200° FOV
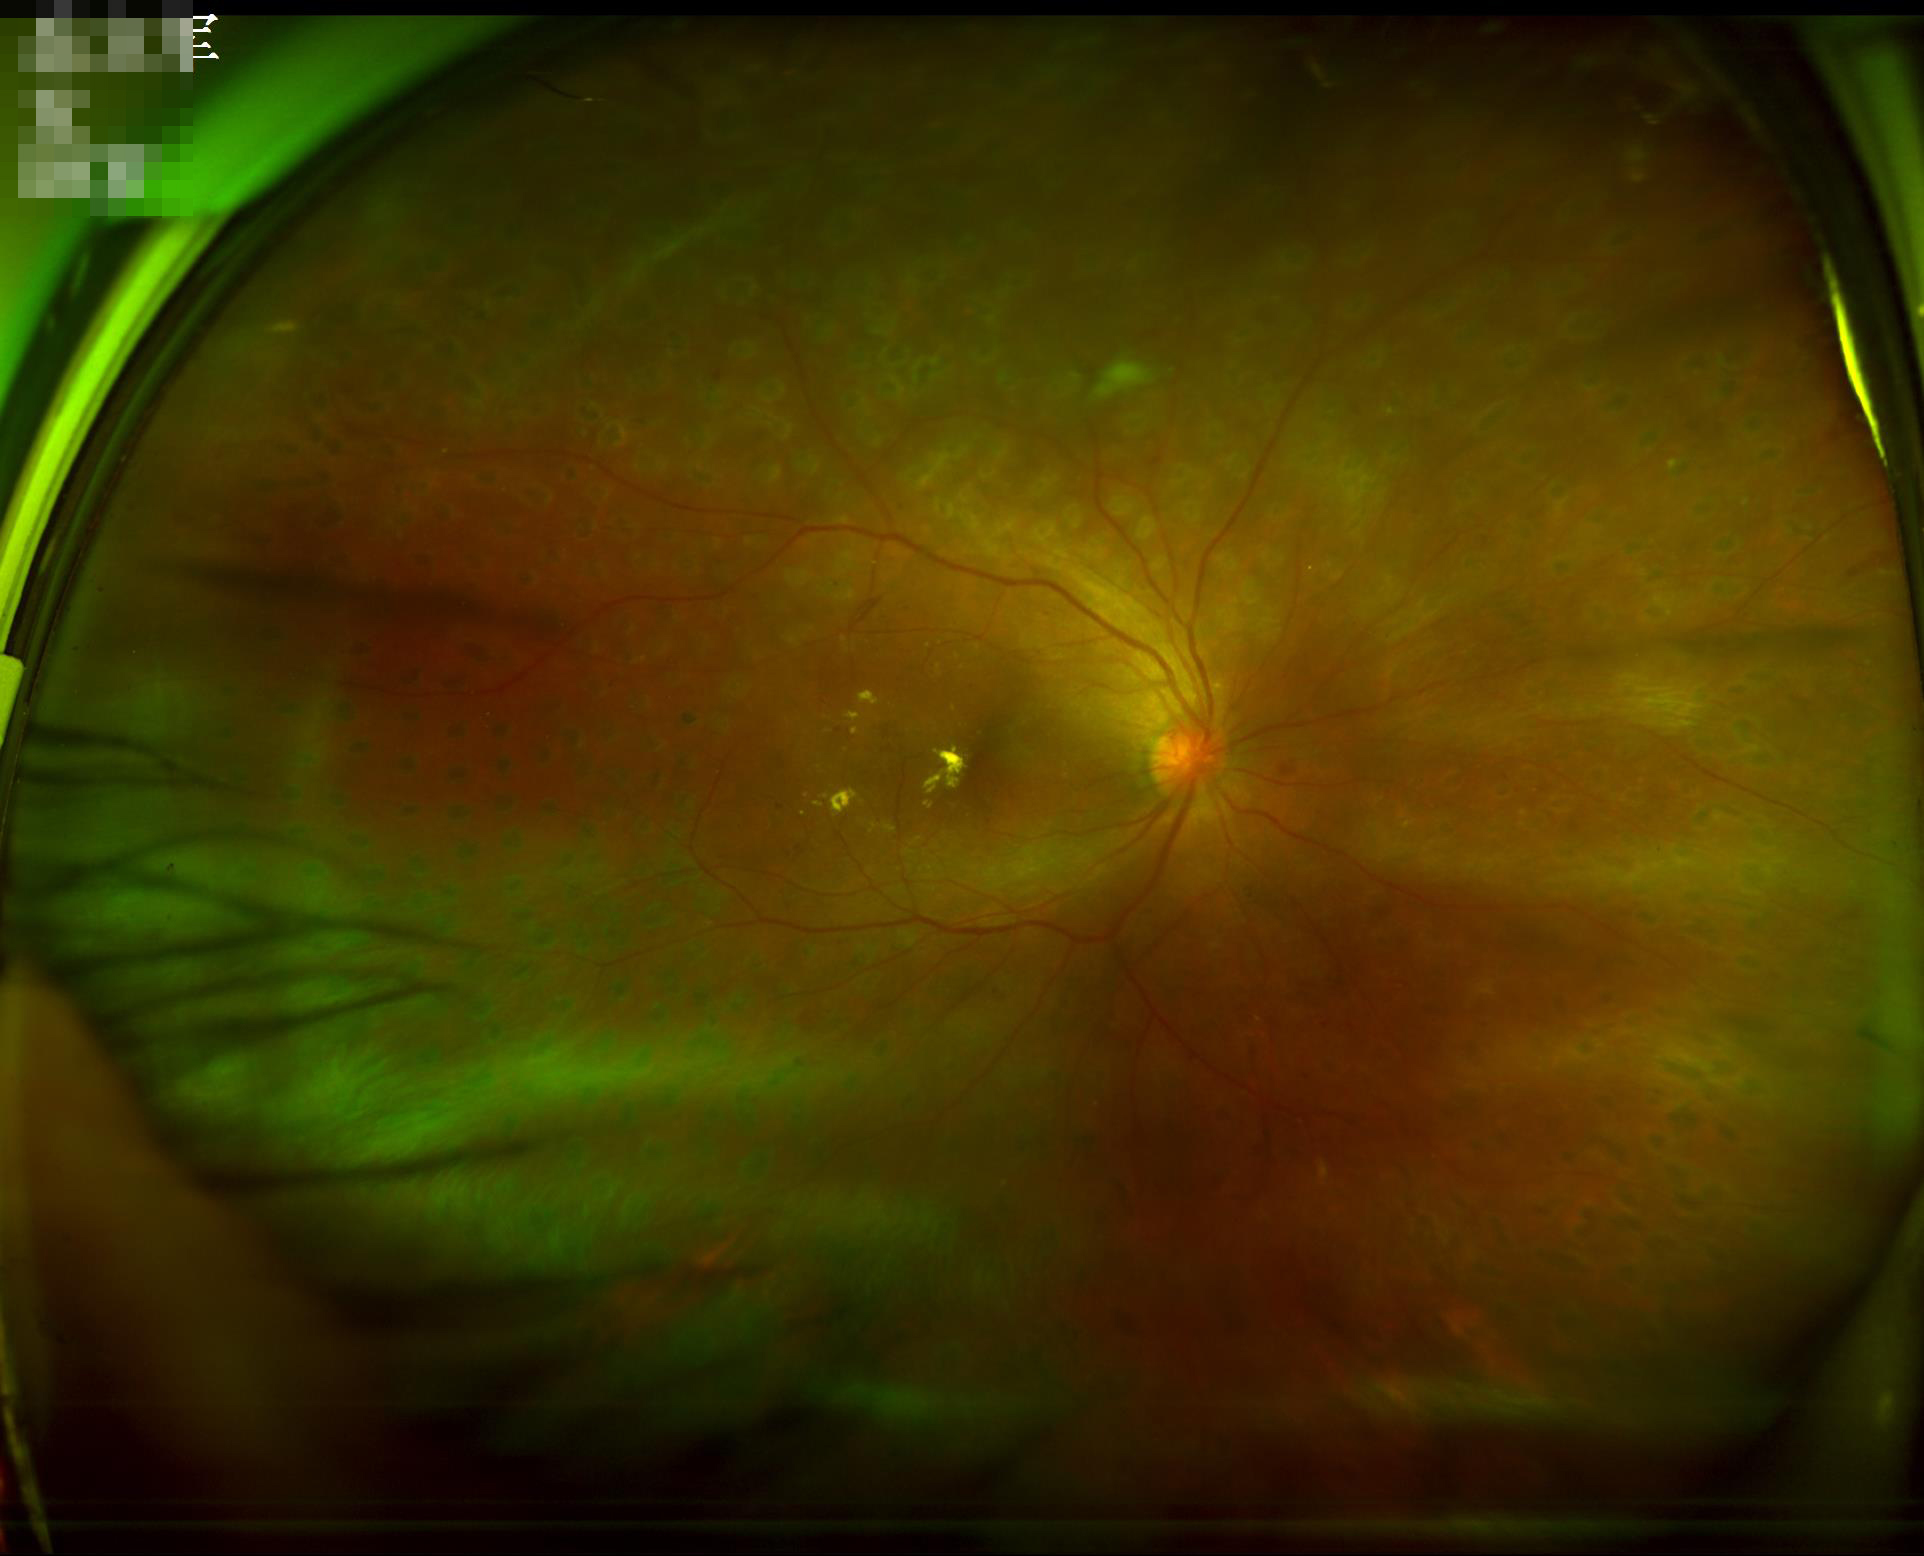 Image quality assessment: overall: good, gradable | focus: reduced sharpness with visible blur.